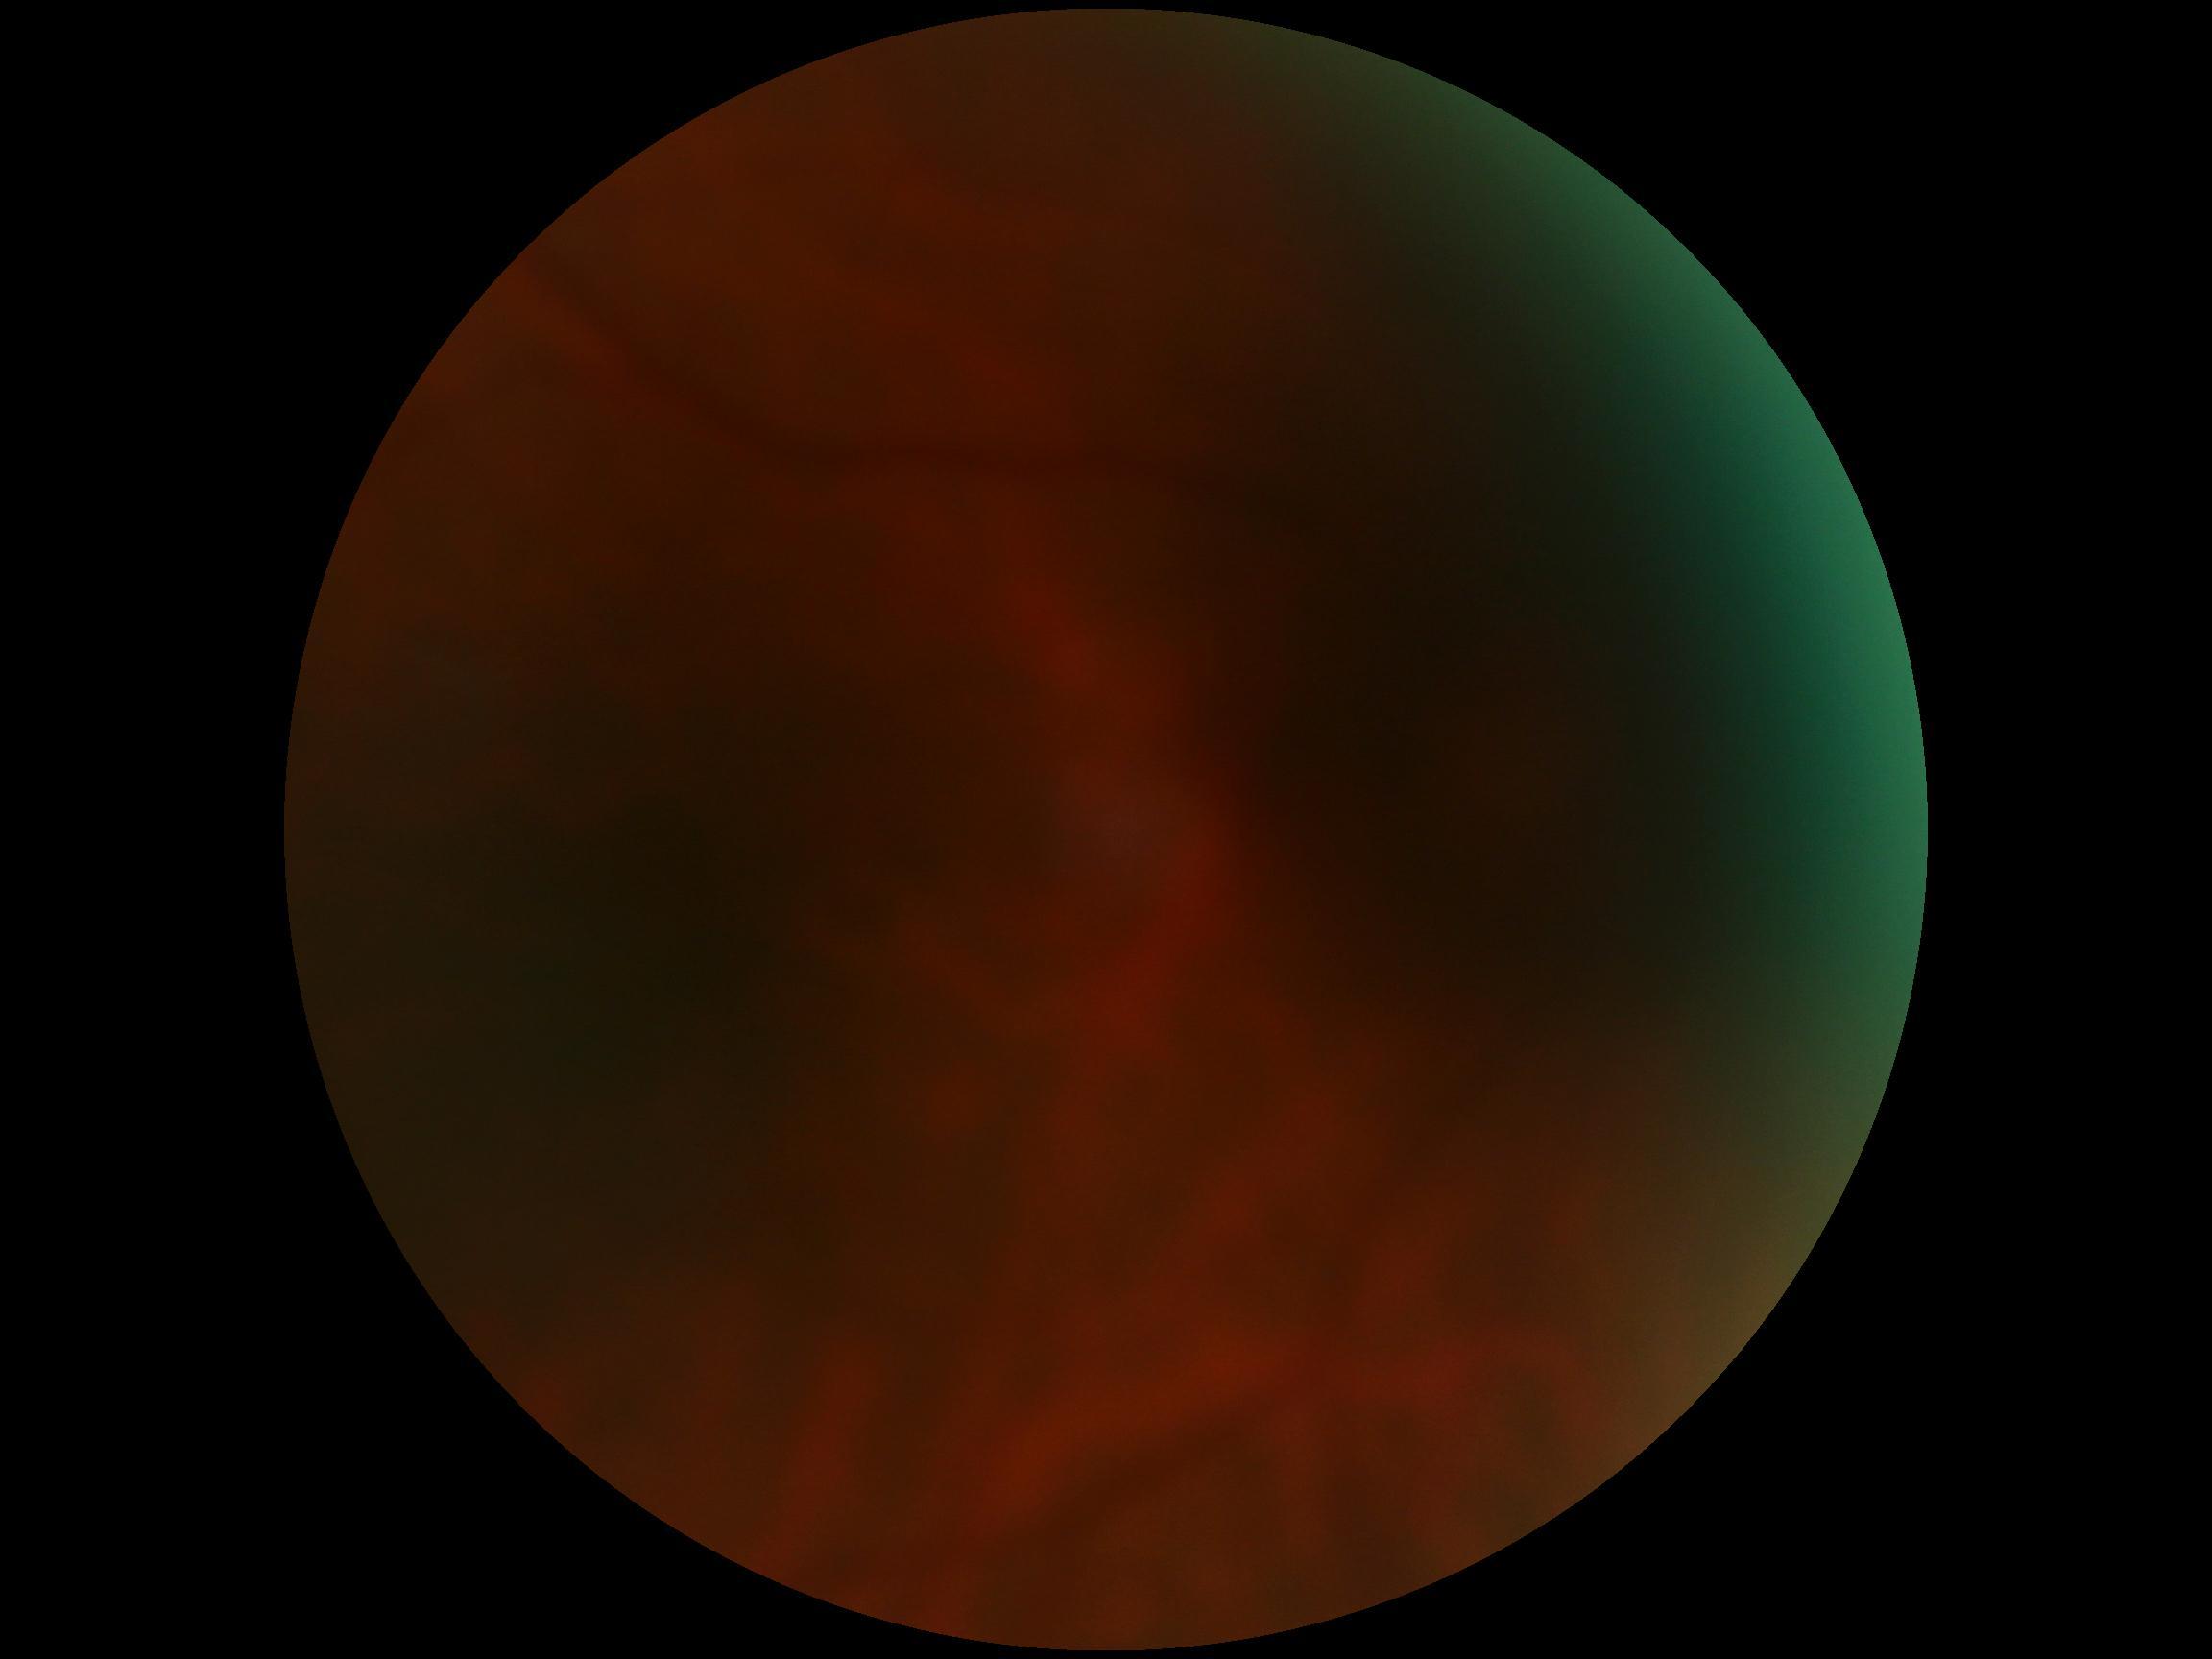

Diabetic retinopathy (DR): ungradable.